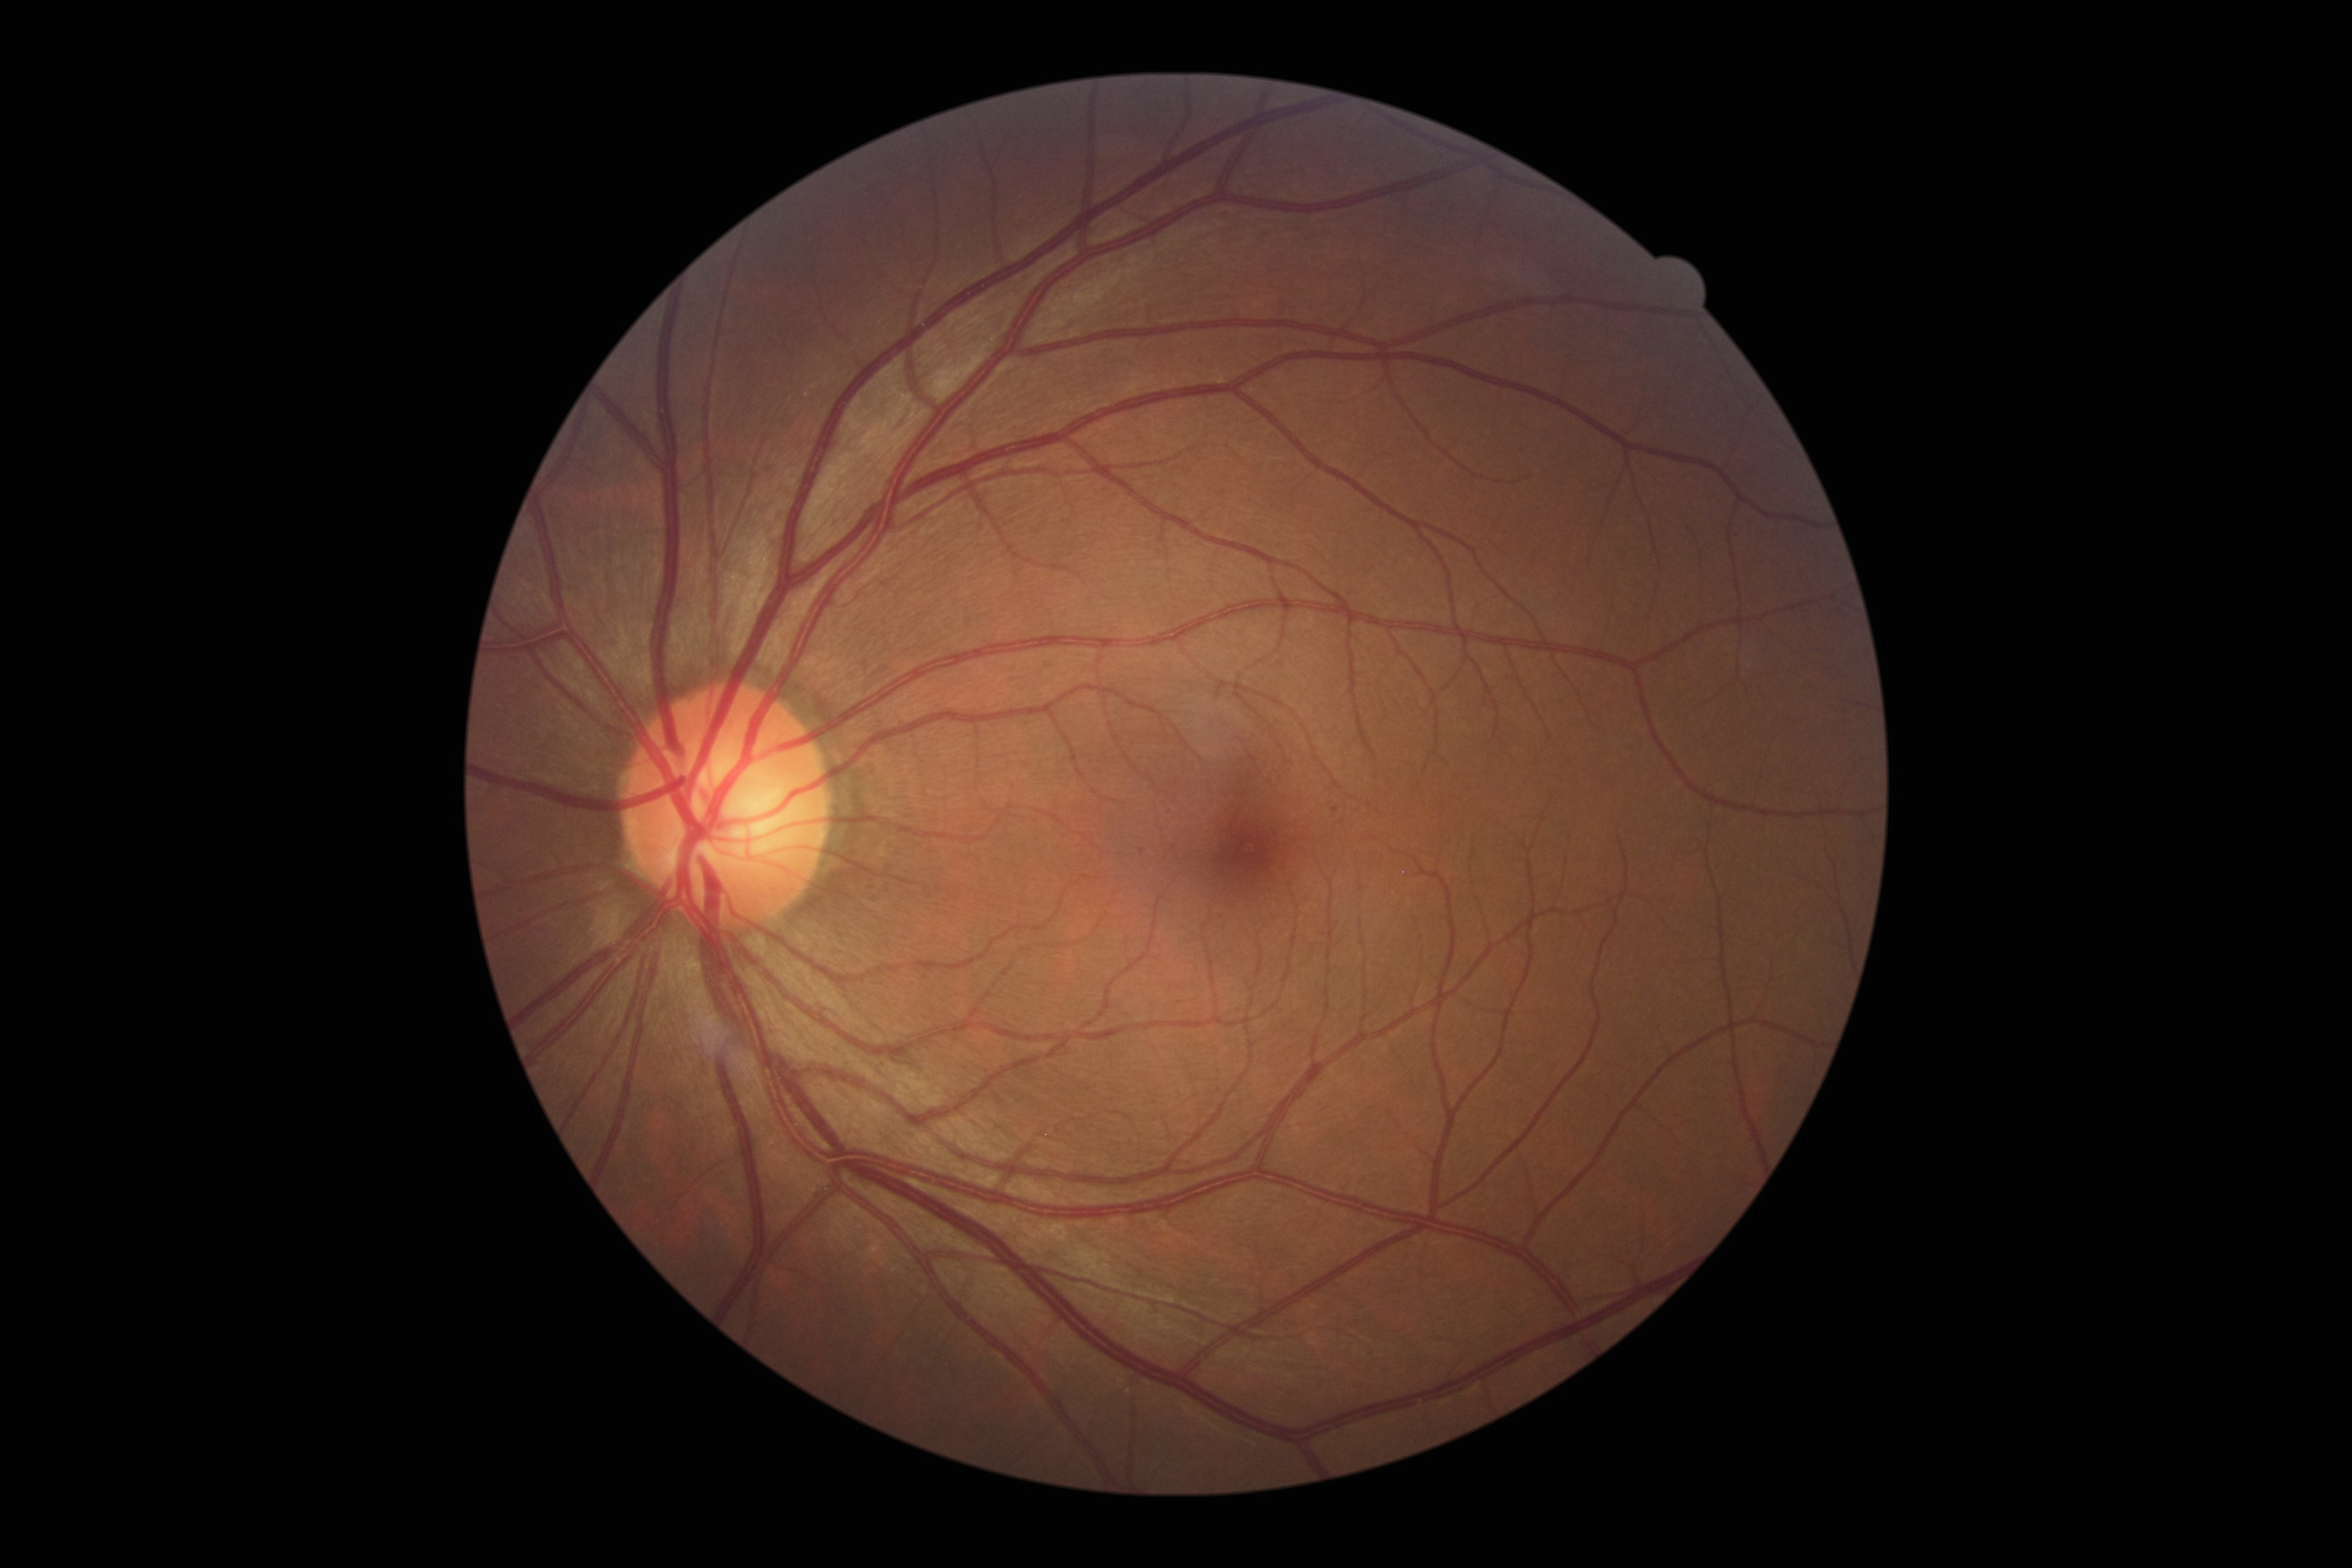
DR is grade 1 (mild NPDR); non-proliferative diabetic retinopathy. Small MAs near 1142:852; 1336:809. No HEs identified. No EXs identified. No SEs identified.